848x848 · diabetic retinopathy graded by the modified Davis classification
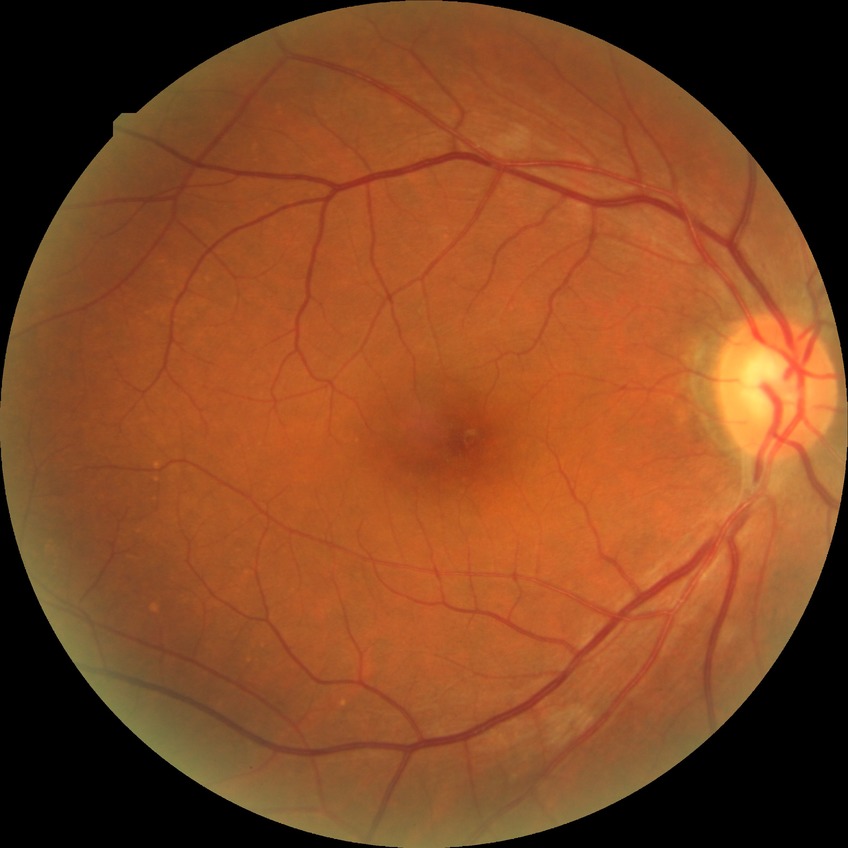
diabetic retinopathy (DR)=SDR (simple diabetic retinopathy).